Retinal fundus photograph: 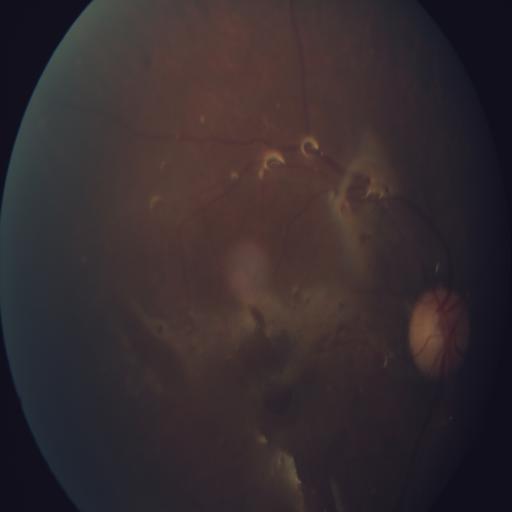
Findings consistent with macular scar.